DR severity per modified Davis staging:
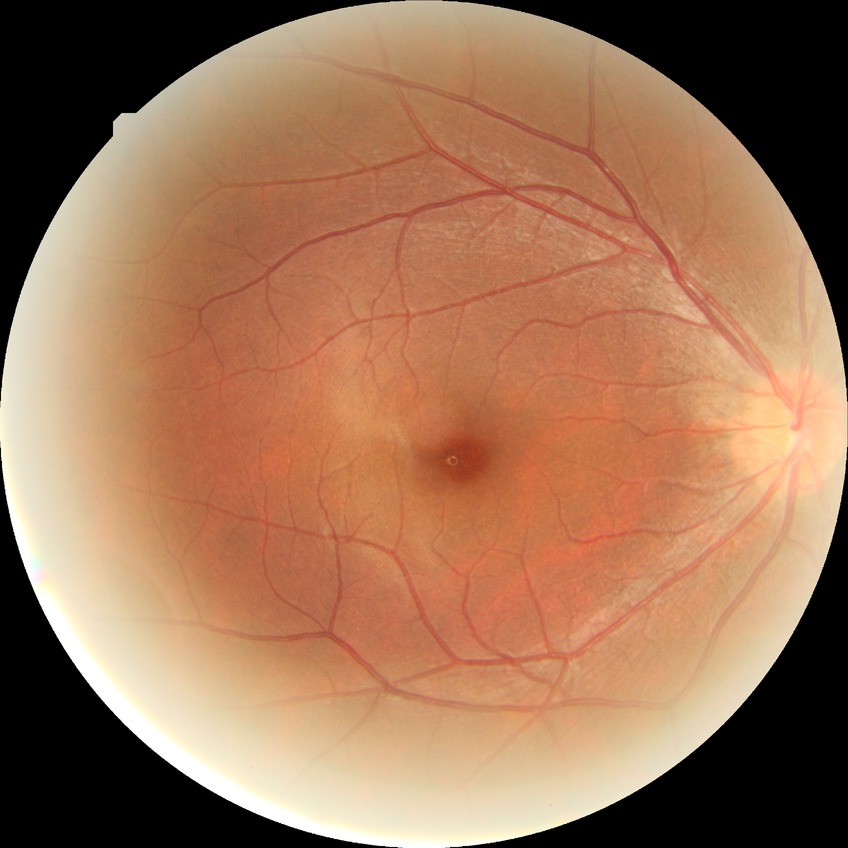 Diabetic retinopathy severity: no diabetic retinopathy.